Infant wide-field retinal image.
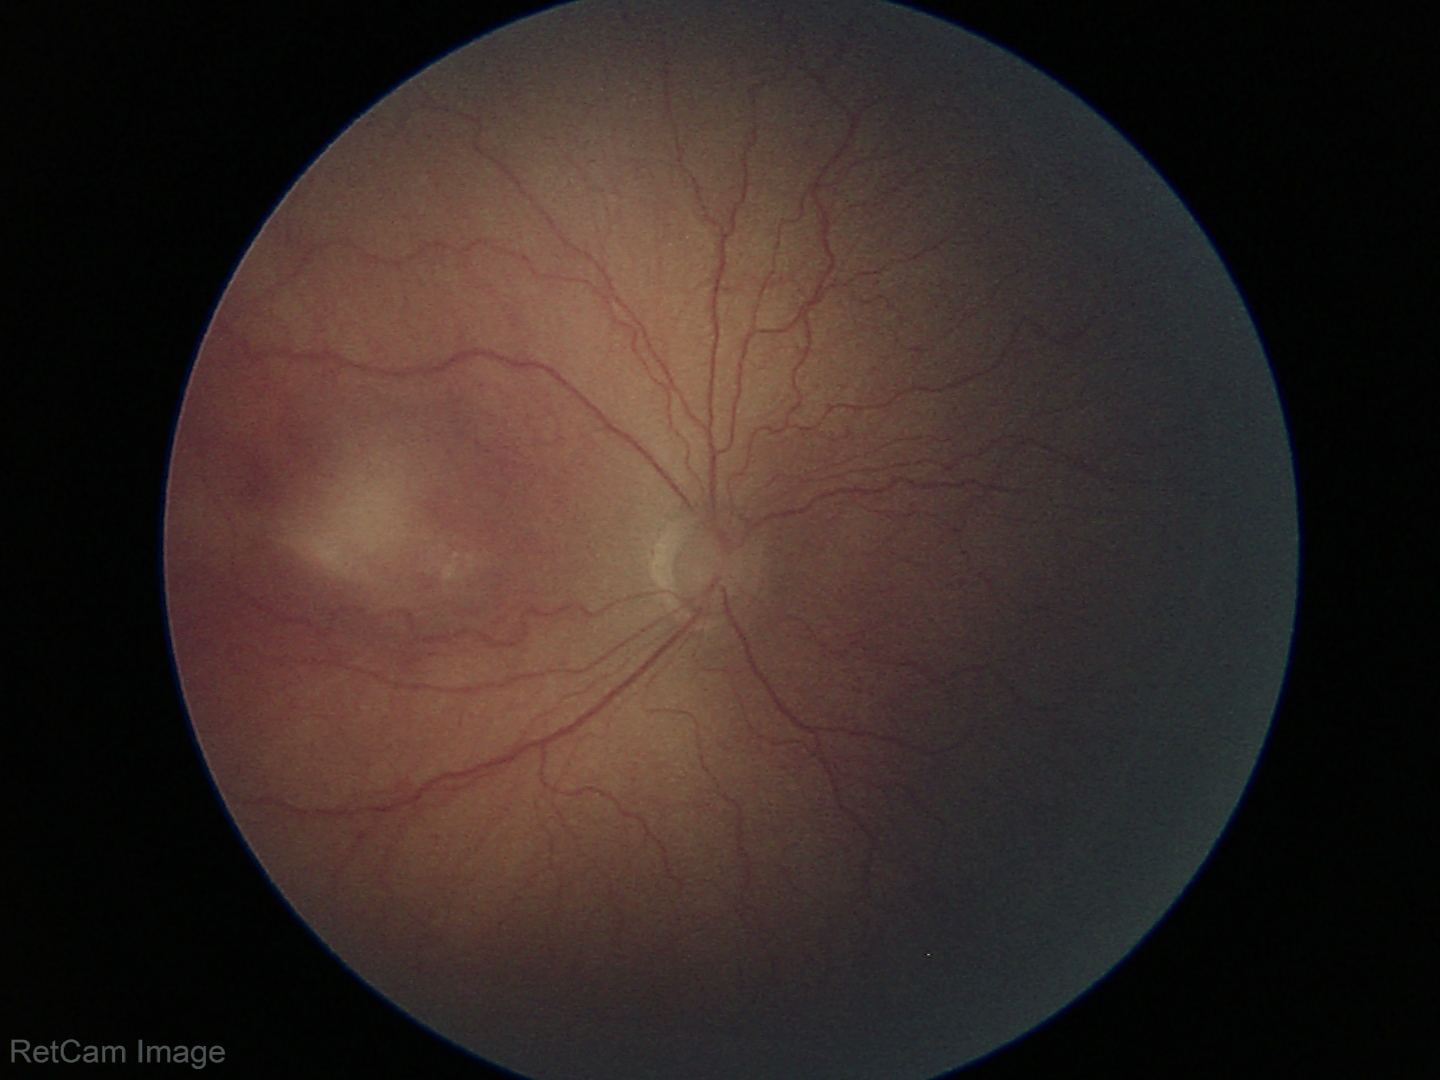 Examination diagnosed as retinopathy of prematurity (ROP) stage 2.